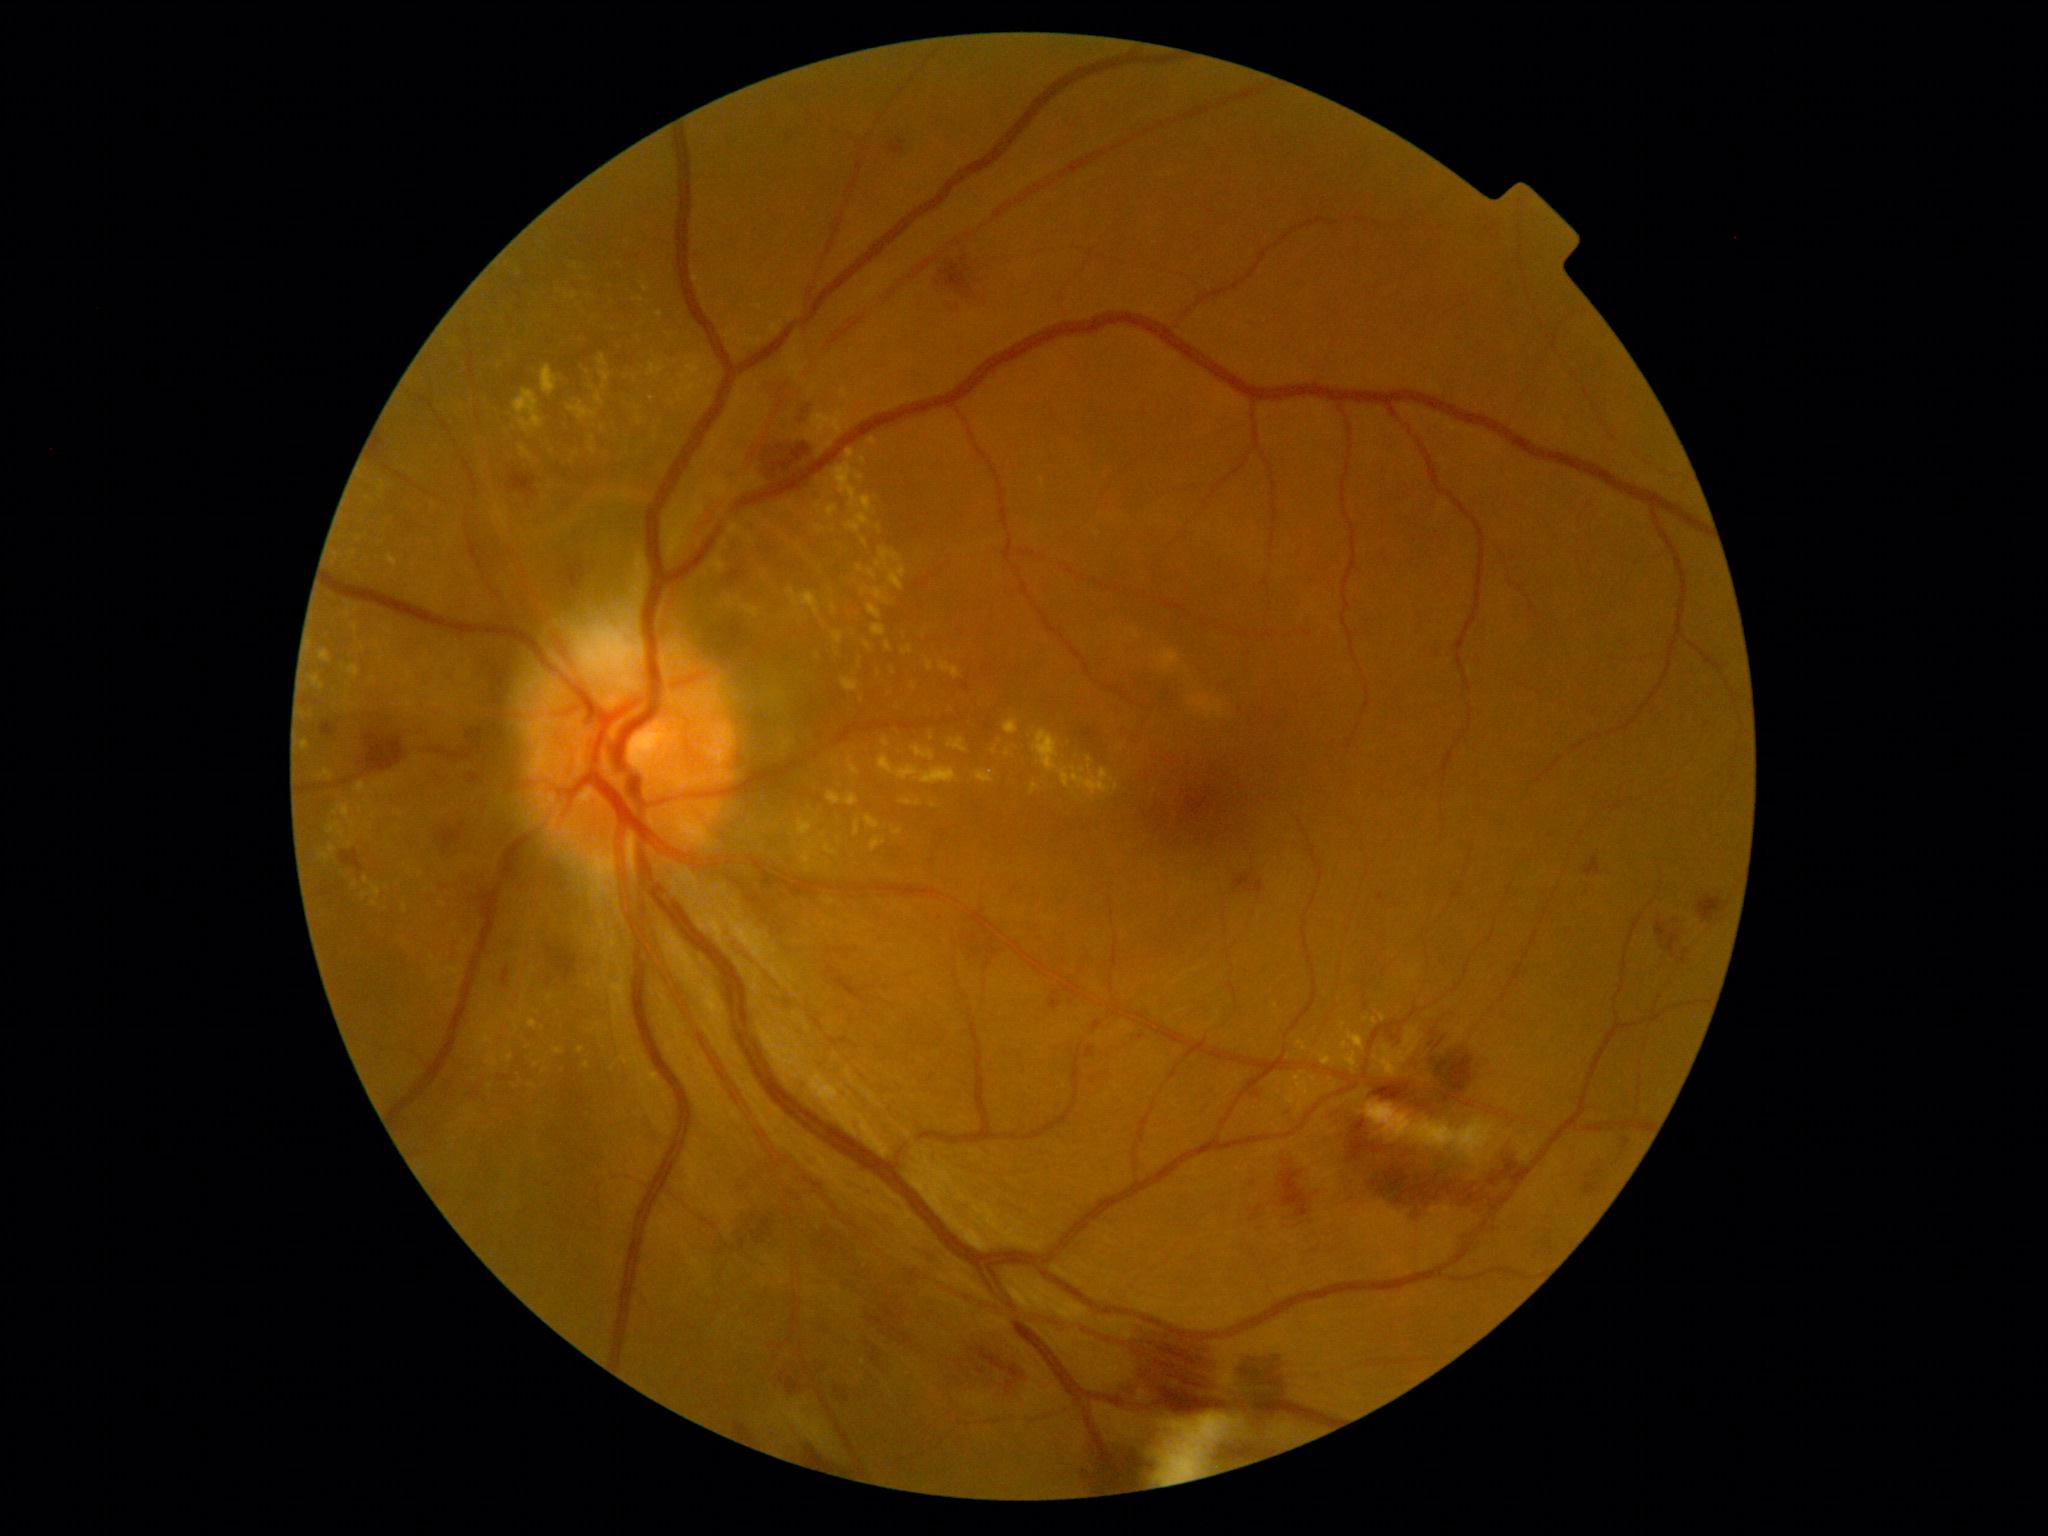
Diabetic retinopathy is grade 2 (moderate NPDR).